Clarity RetCam 3, 130° FOV. Wide-field fundus image from infant ROP screening. 640x480
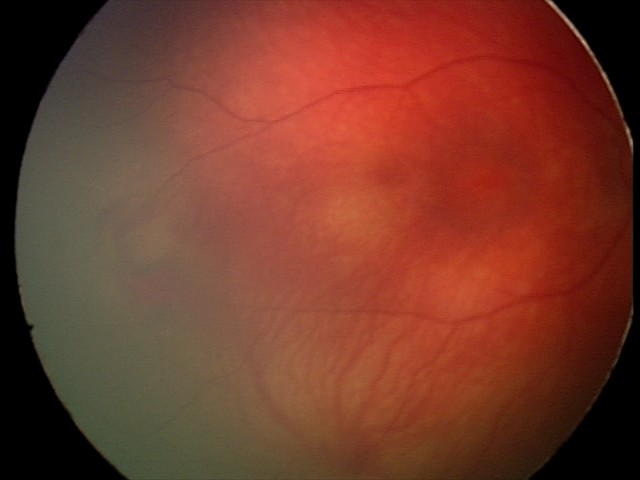
Screening examination consistent with retinal hemorrhages.